Wide-field contact fundus photograph of an infant · 1240 x 1240 pixels.
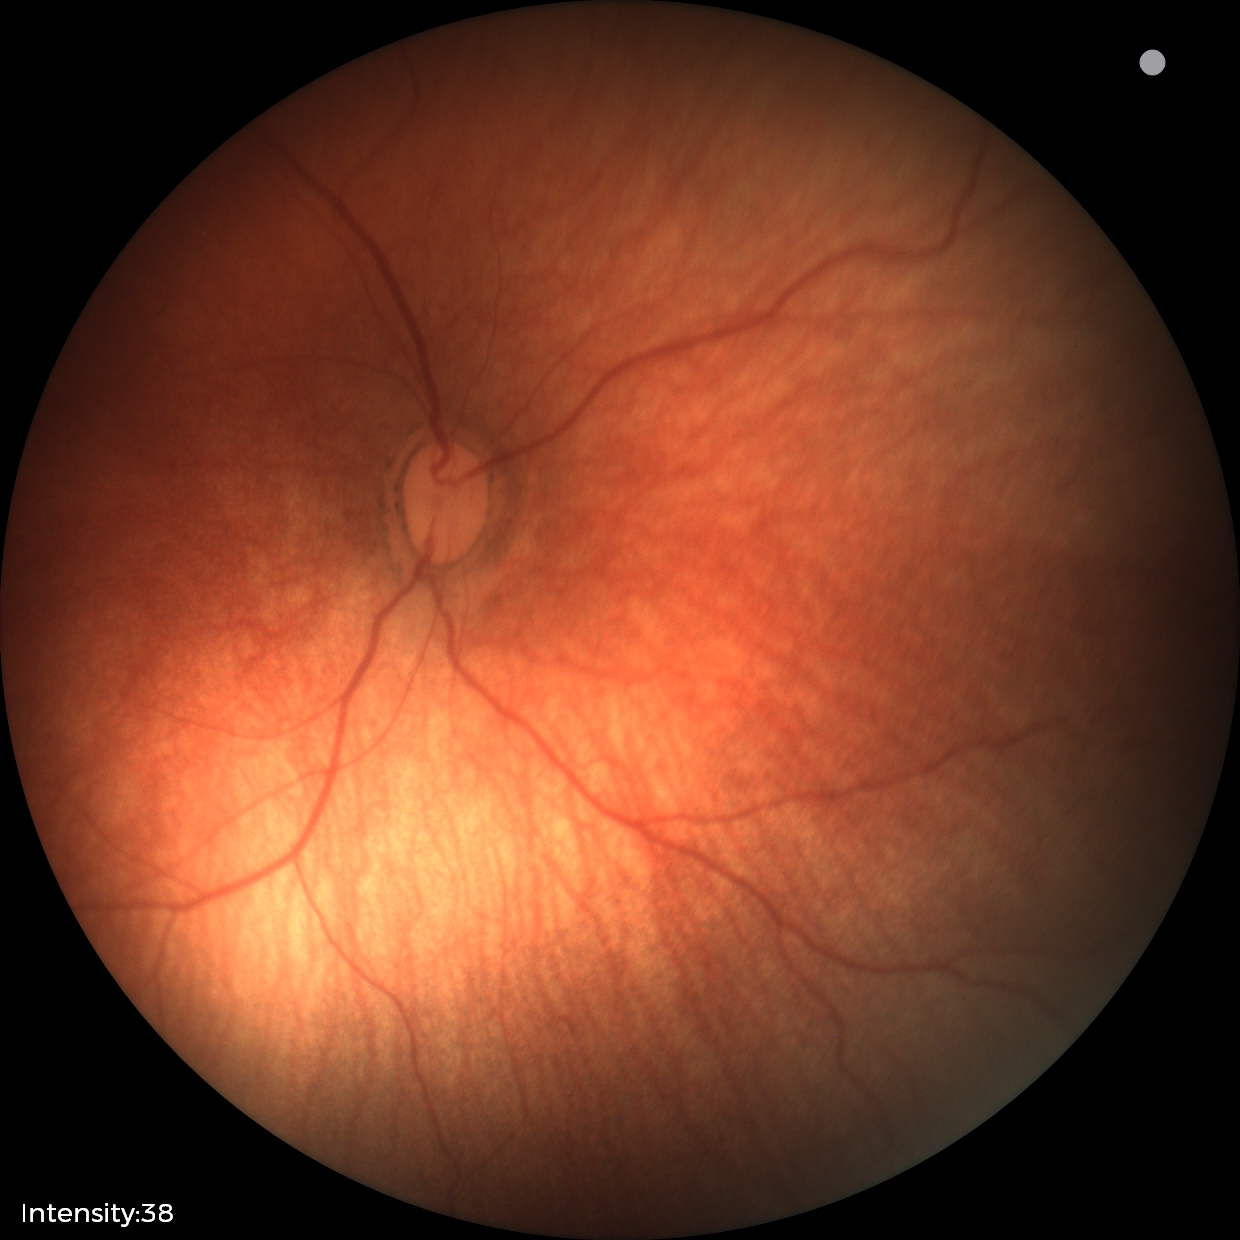

Finding = physiological.